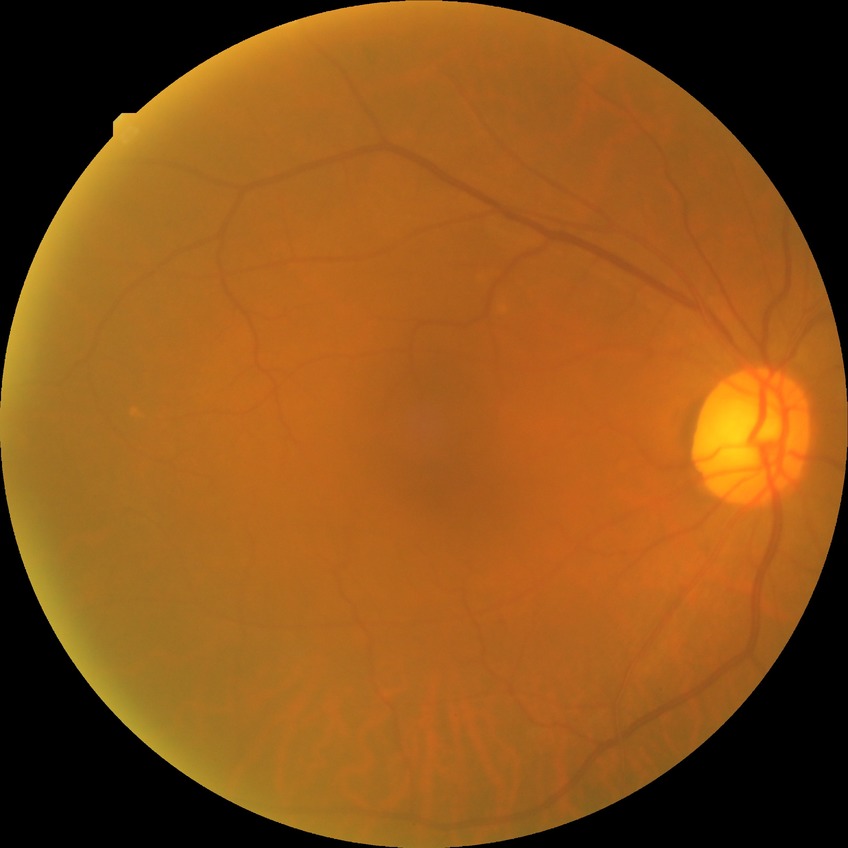 Diabetic retinopathy (DR): no diabetic retinopathy (NDR).